Infant wide-field fundus photograph. Phoenix ICON, 100° FOV.
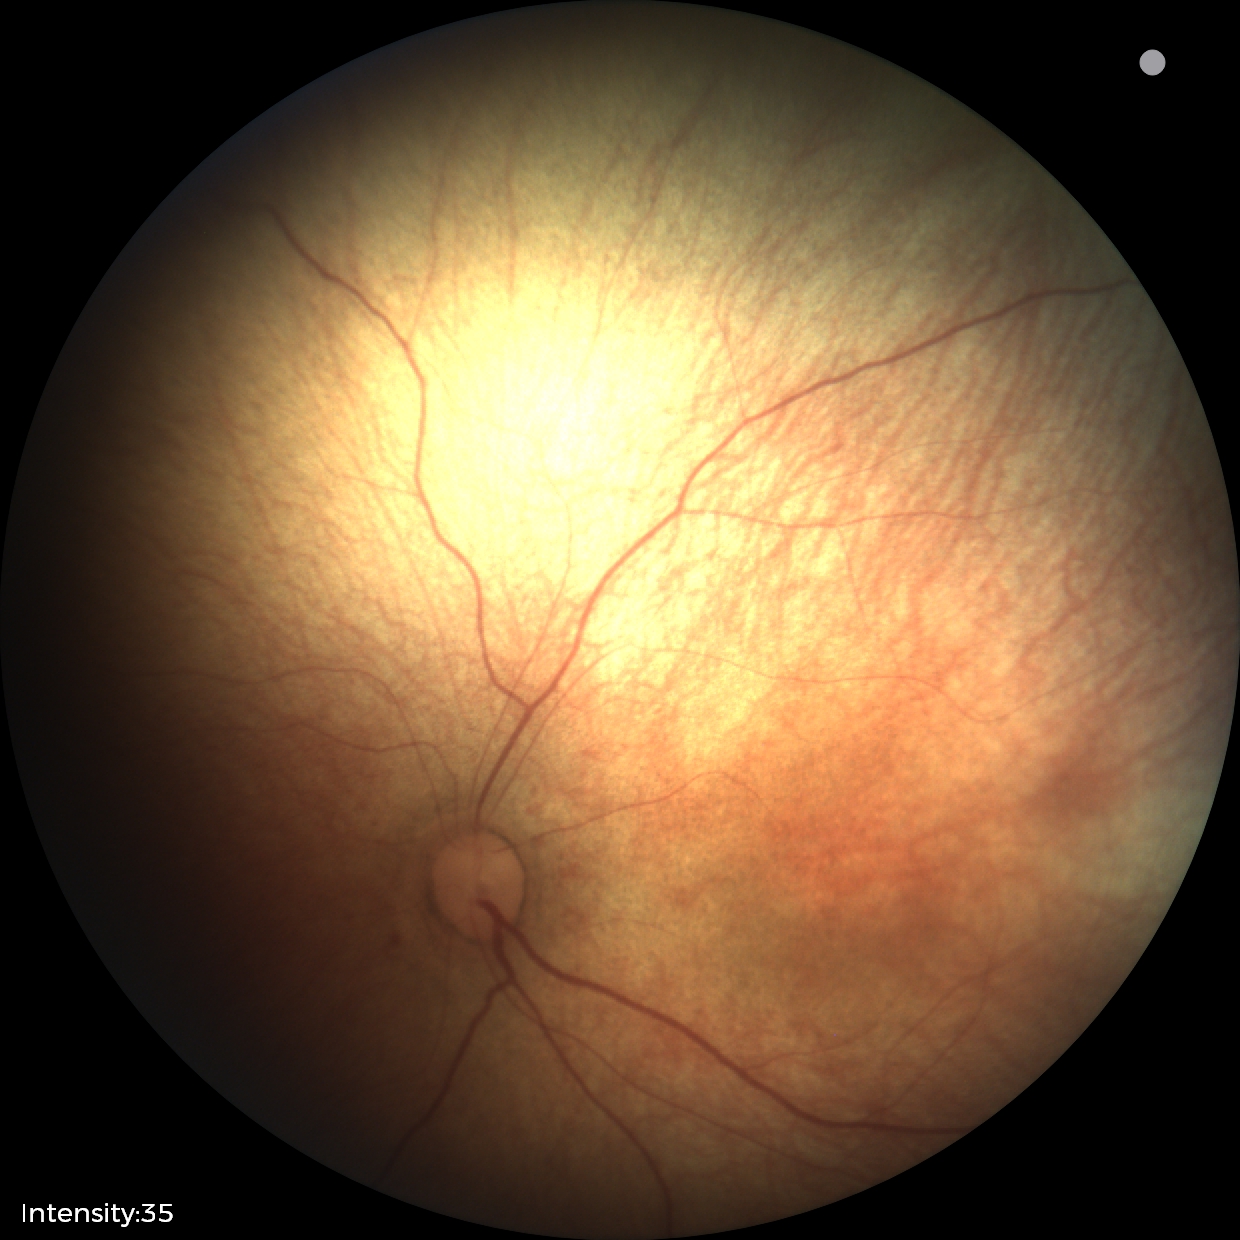

Q: What is the diagnosis from this examination?
A: normal retinal appearance